1659x2212px.
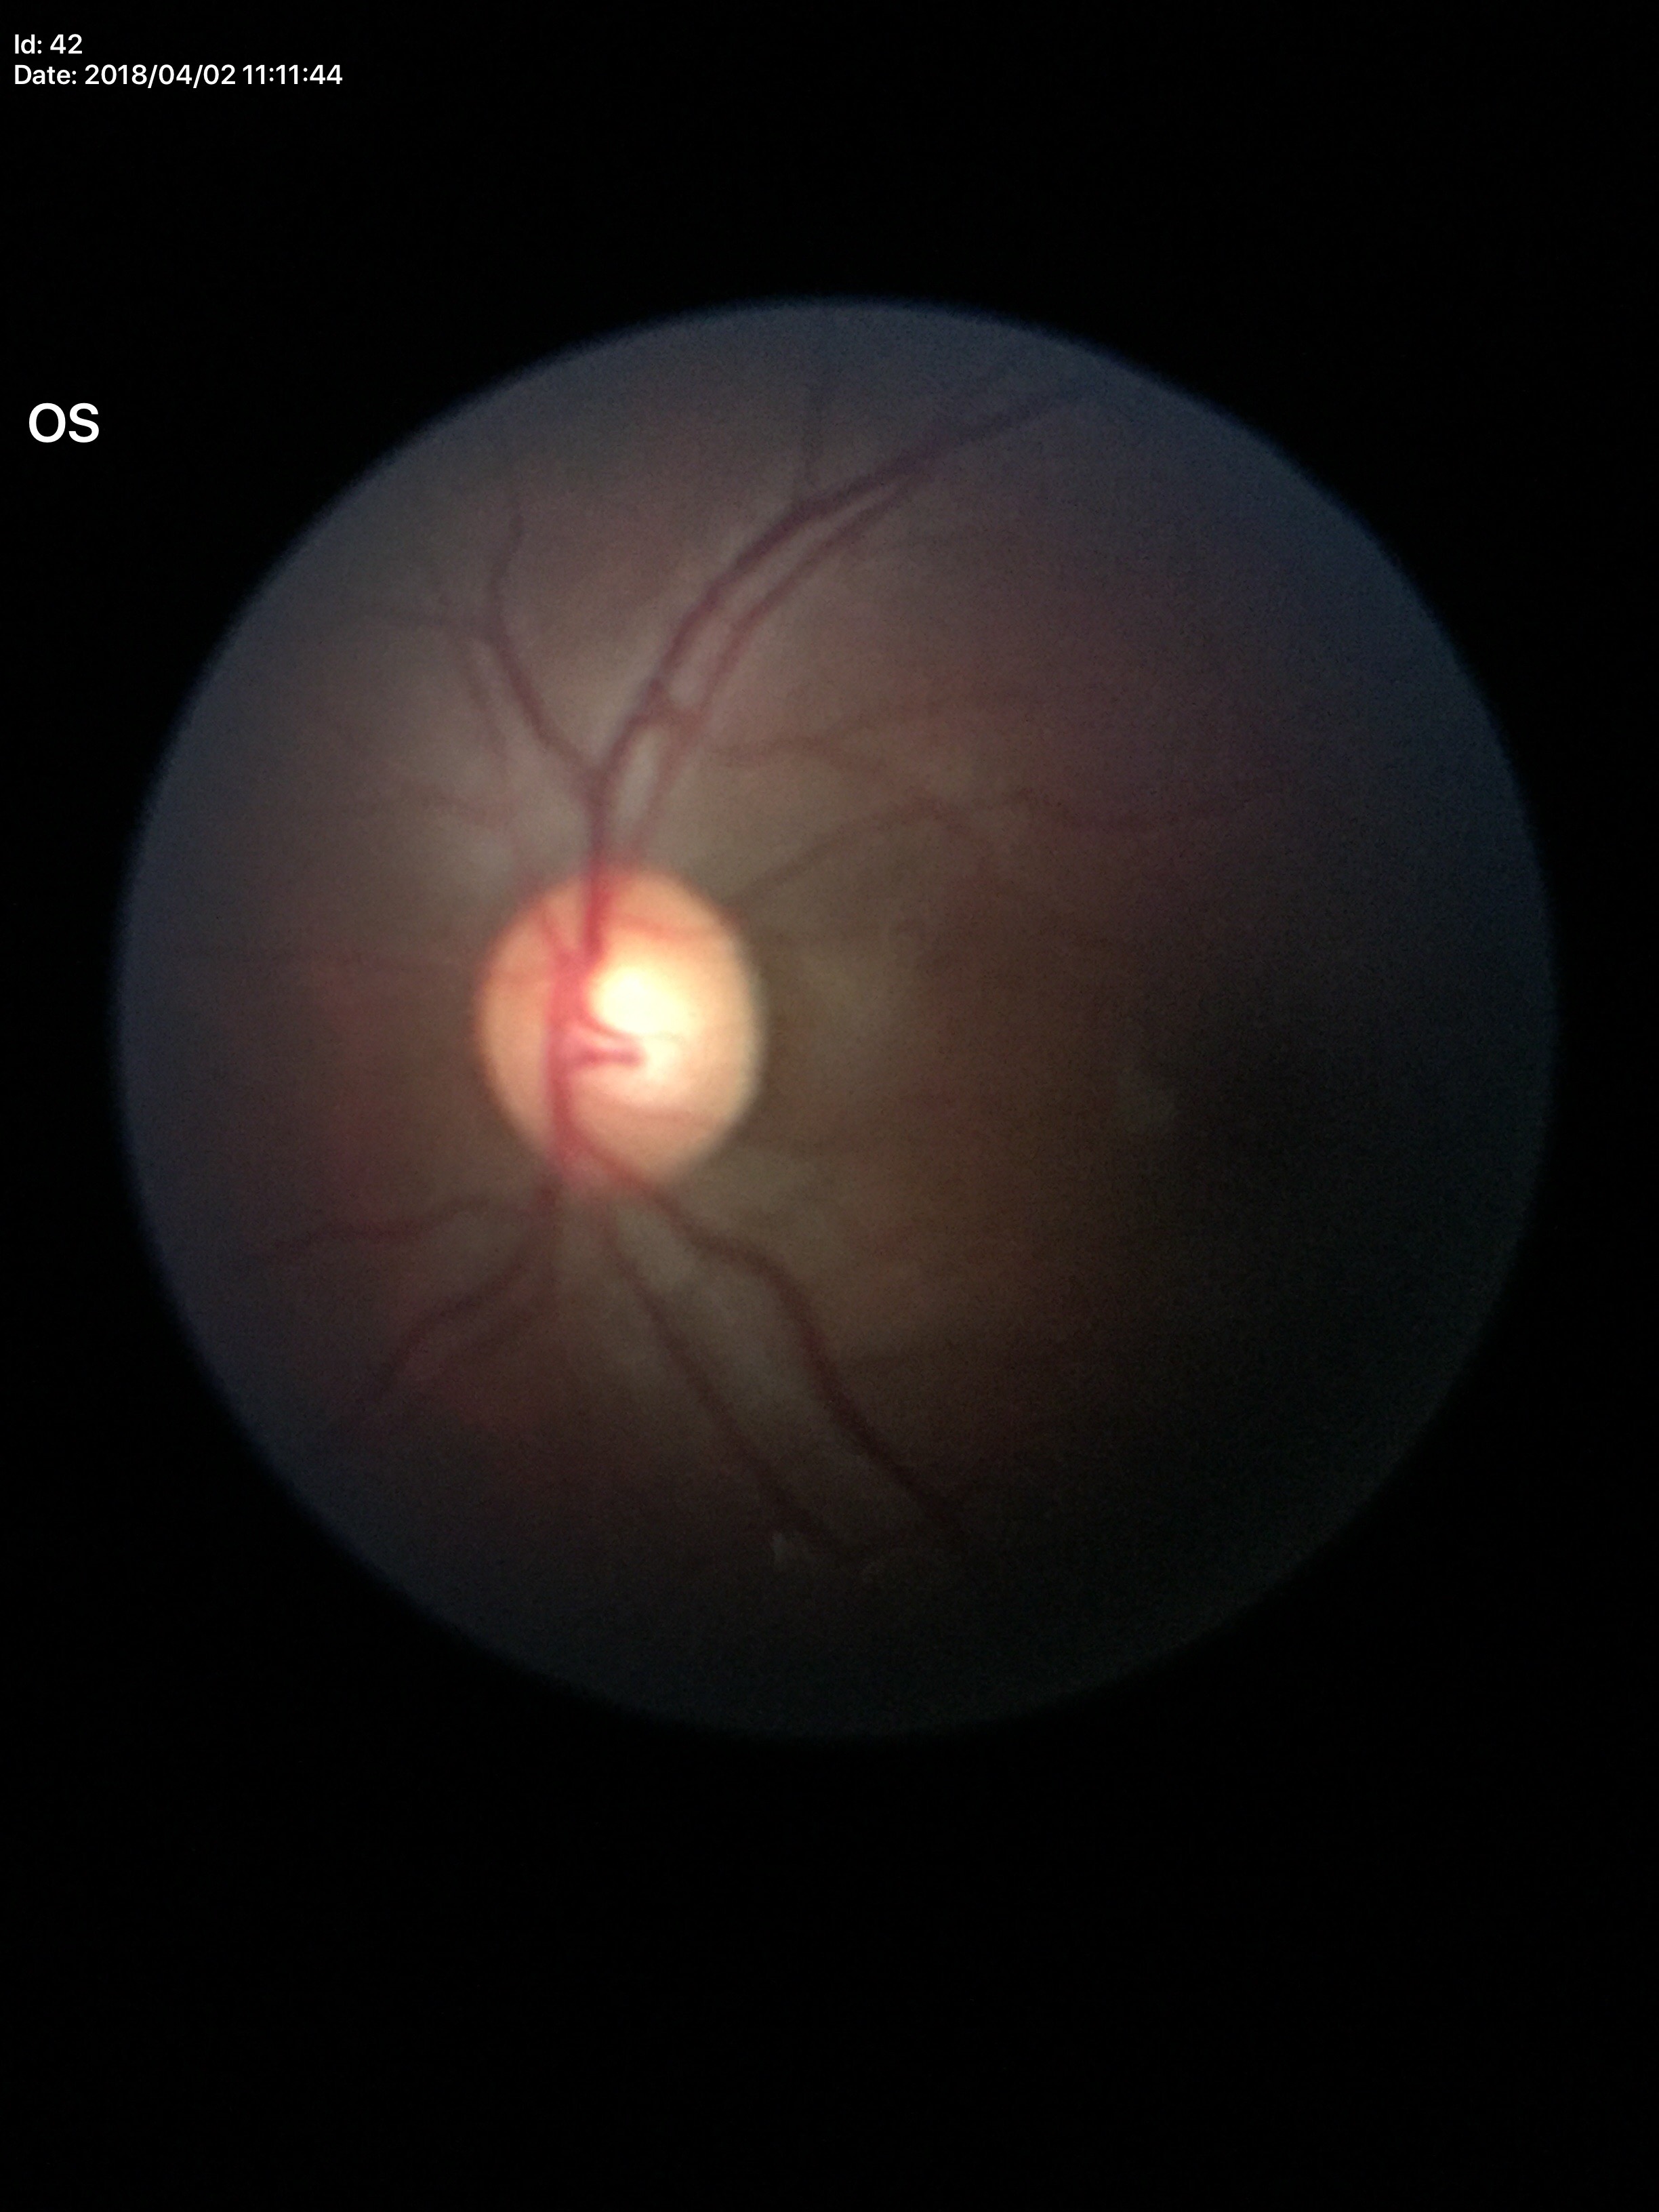

Glaucoma evaluation: negative (5/5 ophthalmologists in agreement) | vertical C/D ratio: 0.57 | horizontal CDR: 0.59.